Wide-field fundus photograph from neonatal ROP screening · 100° field of view (Phoenix ICON): 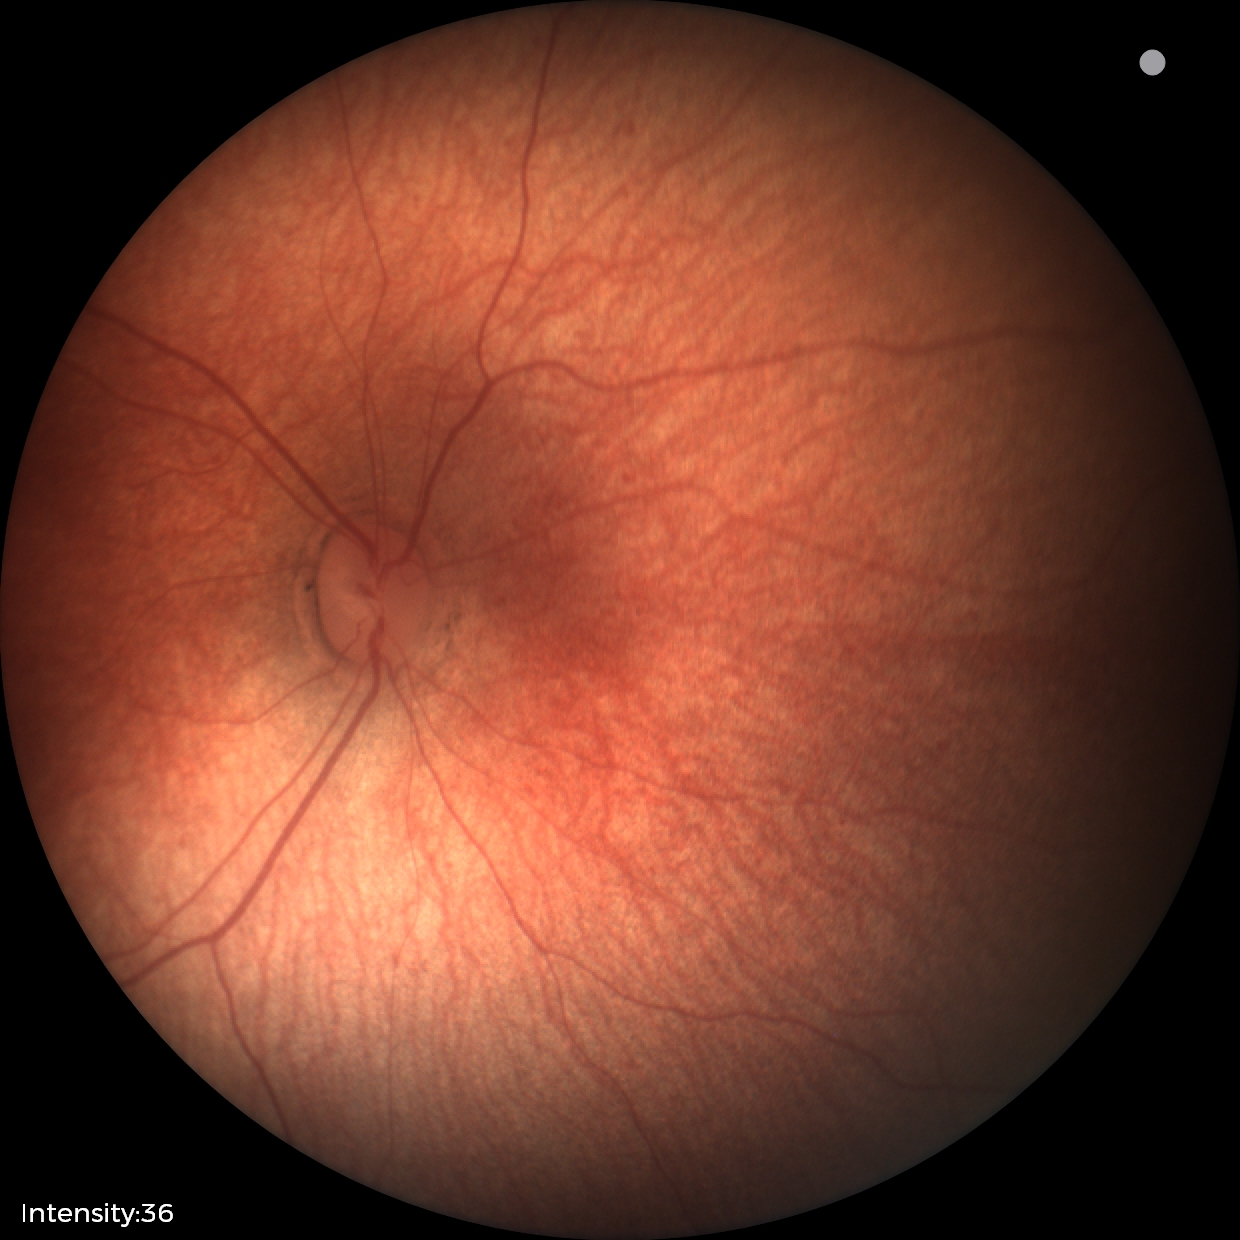 Normal screening examination.